Retinal fundus photograph; acquired with a Remidio smartphone fundus camera; 1659x2212px: 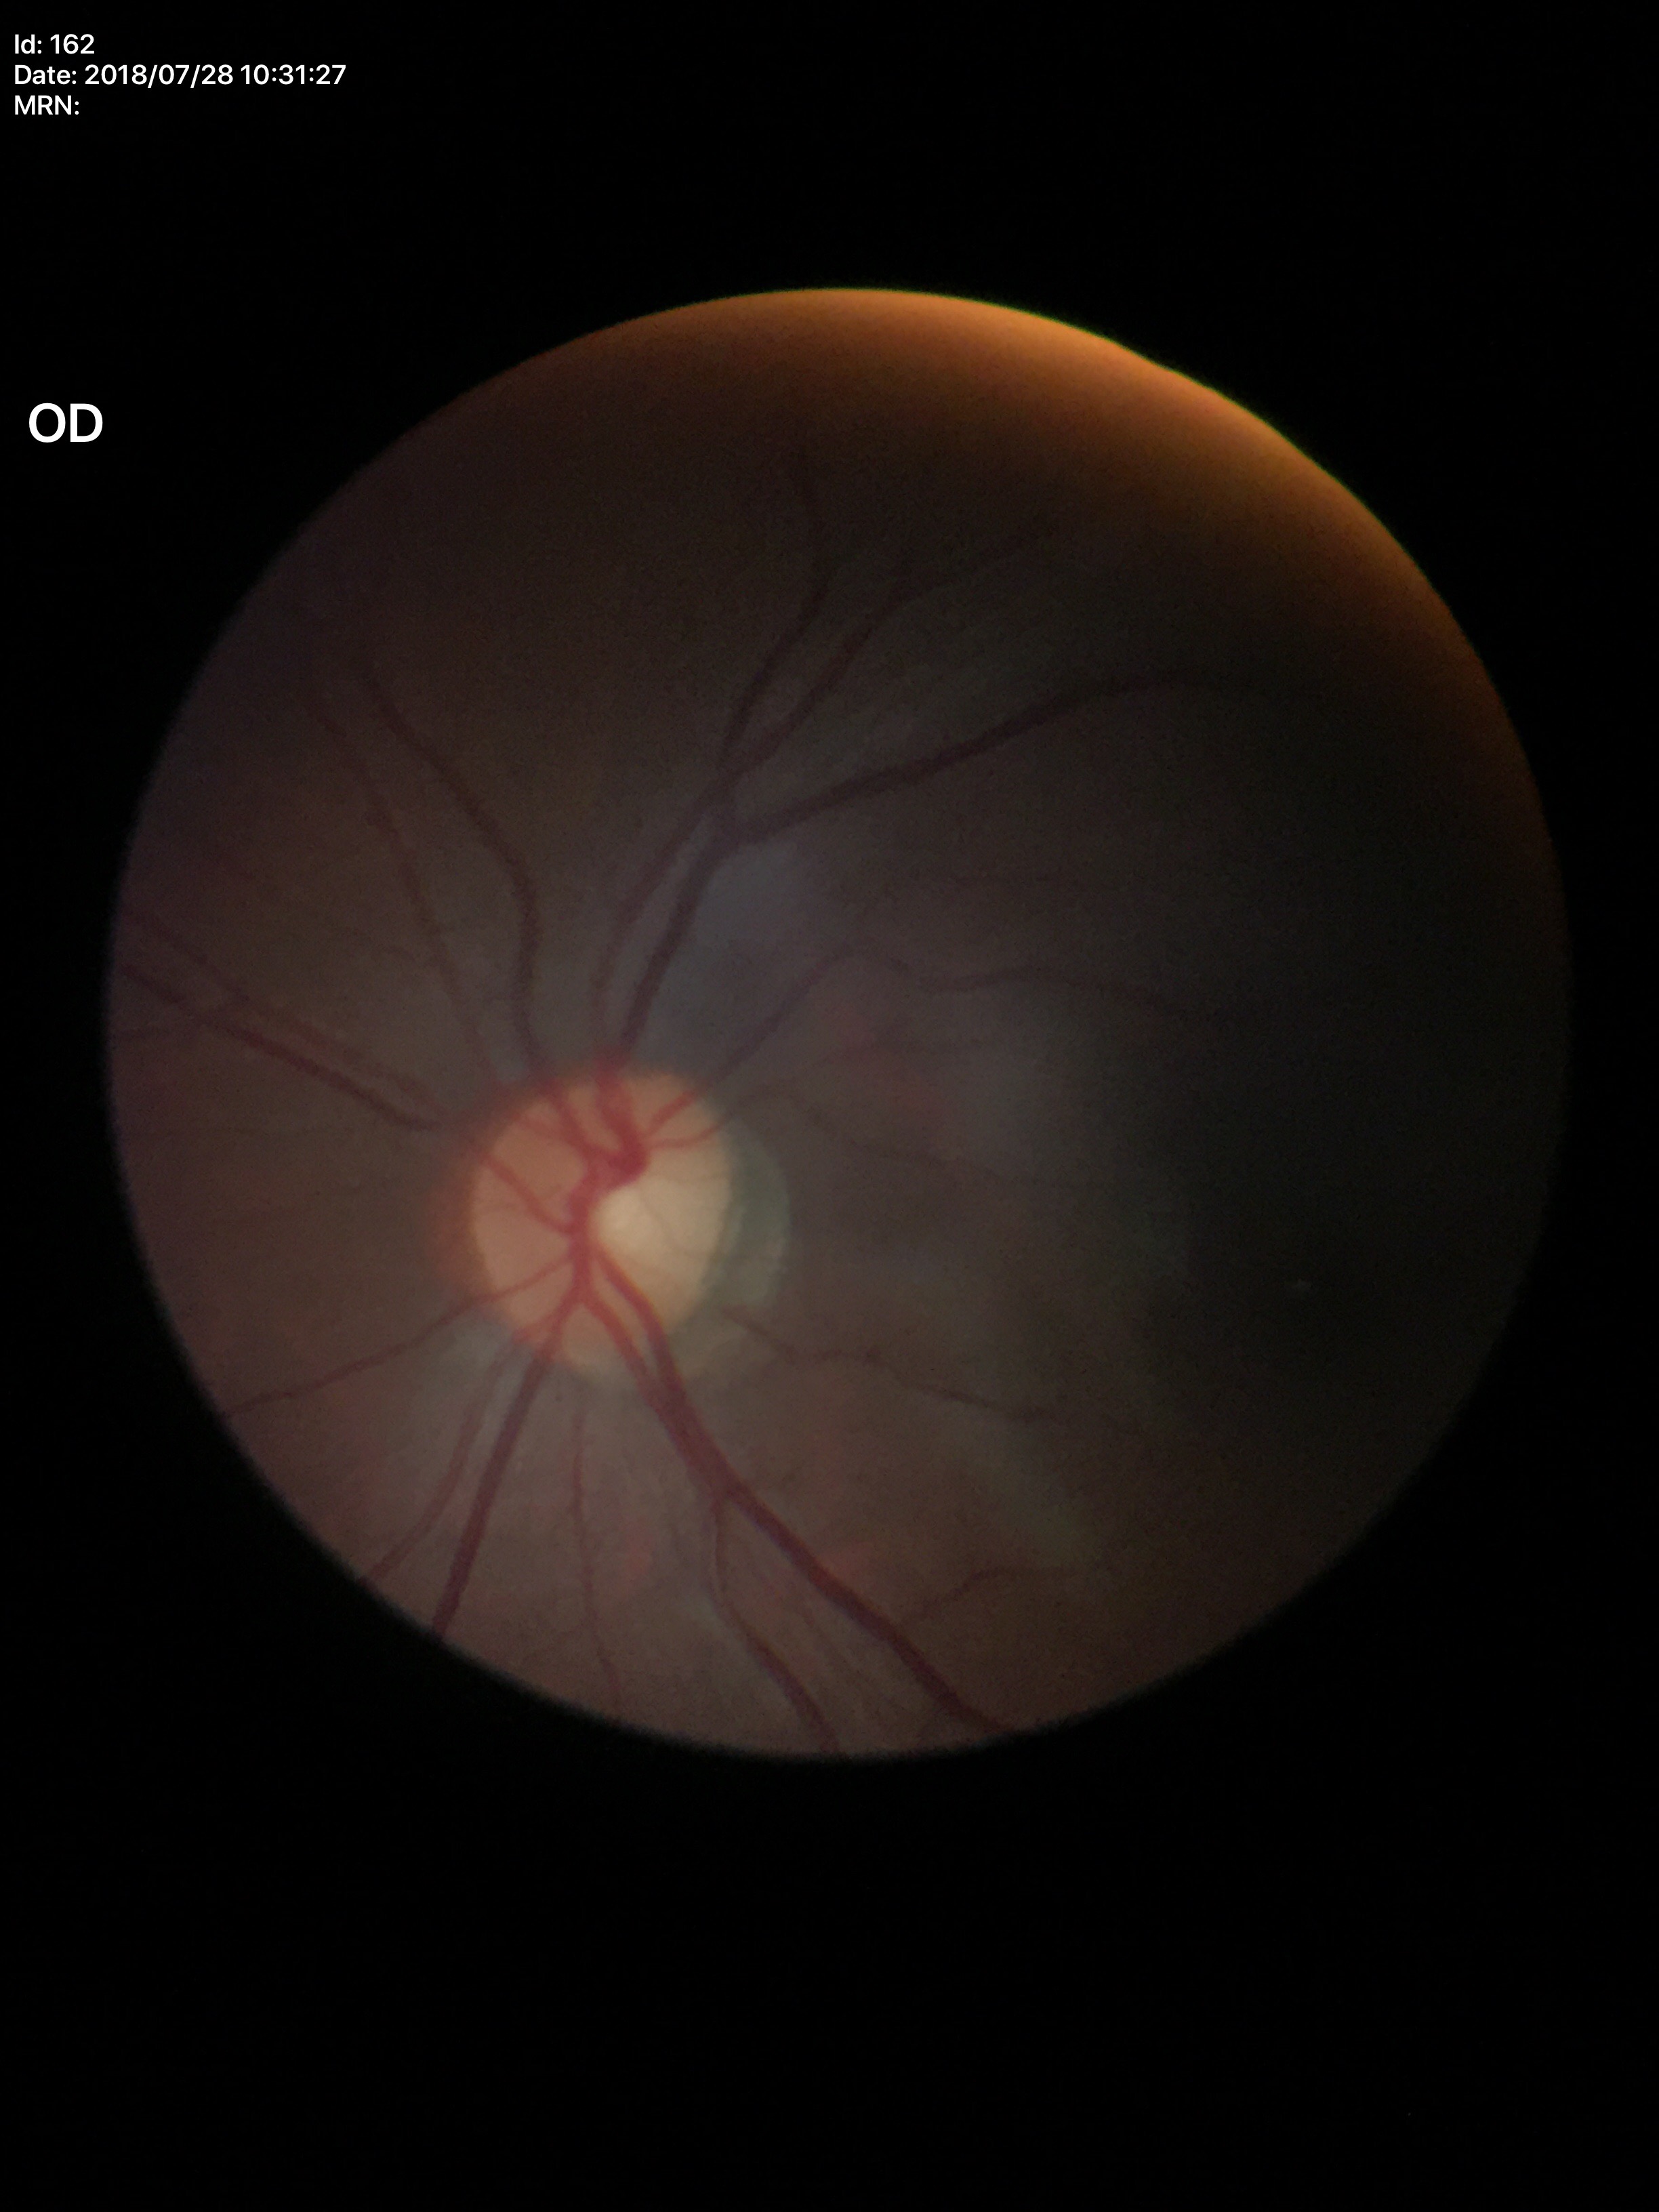
{
  "glaucoma_decision": "no suspicious findings (5/5 ophthalmologists in agreement)",
  "vcdr": "0.45",
  "hcdr": "0.48"
}